Captured without pupil dilation: 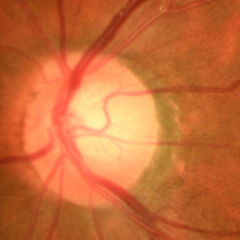 Q: What stage of glaucoma is present?
A: Early-stage glaucoma.